Clarity RetCam 3, 130° FOV; wide-field fundus image from infant ROP screening — 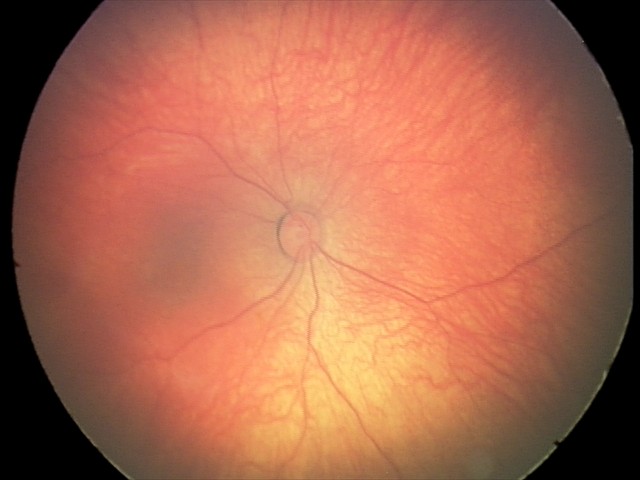
Diagnosis from this screening exam: retinal hemorrhages.